Image size 2212x1659; CFP.
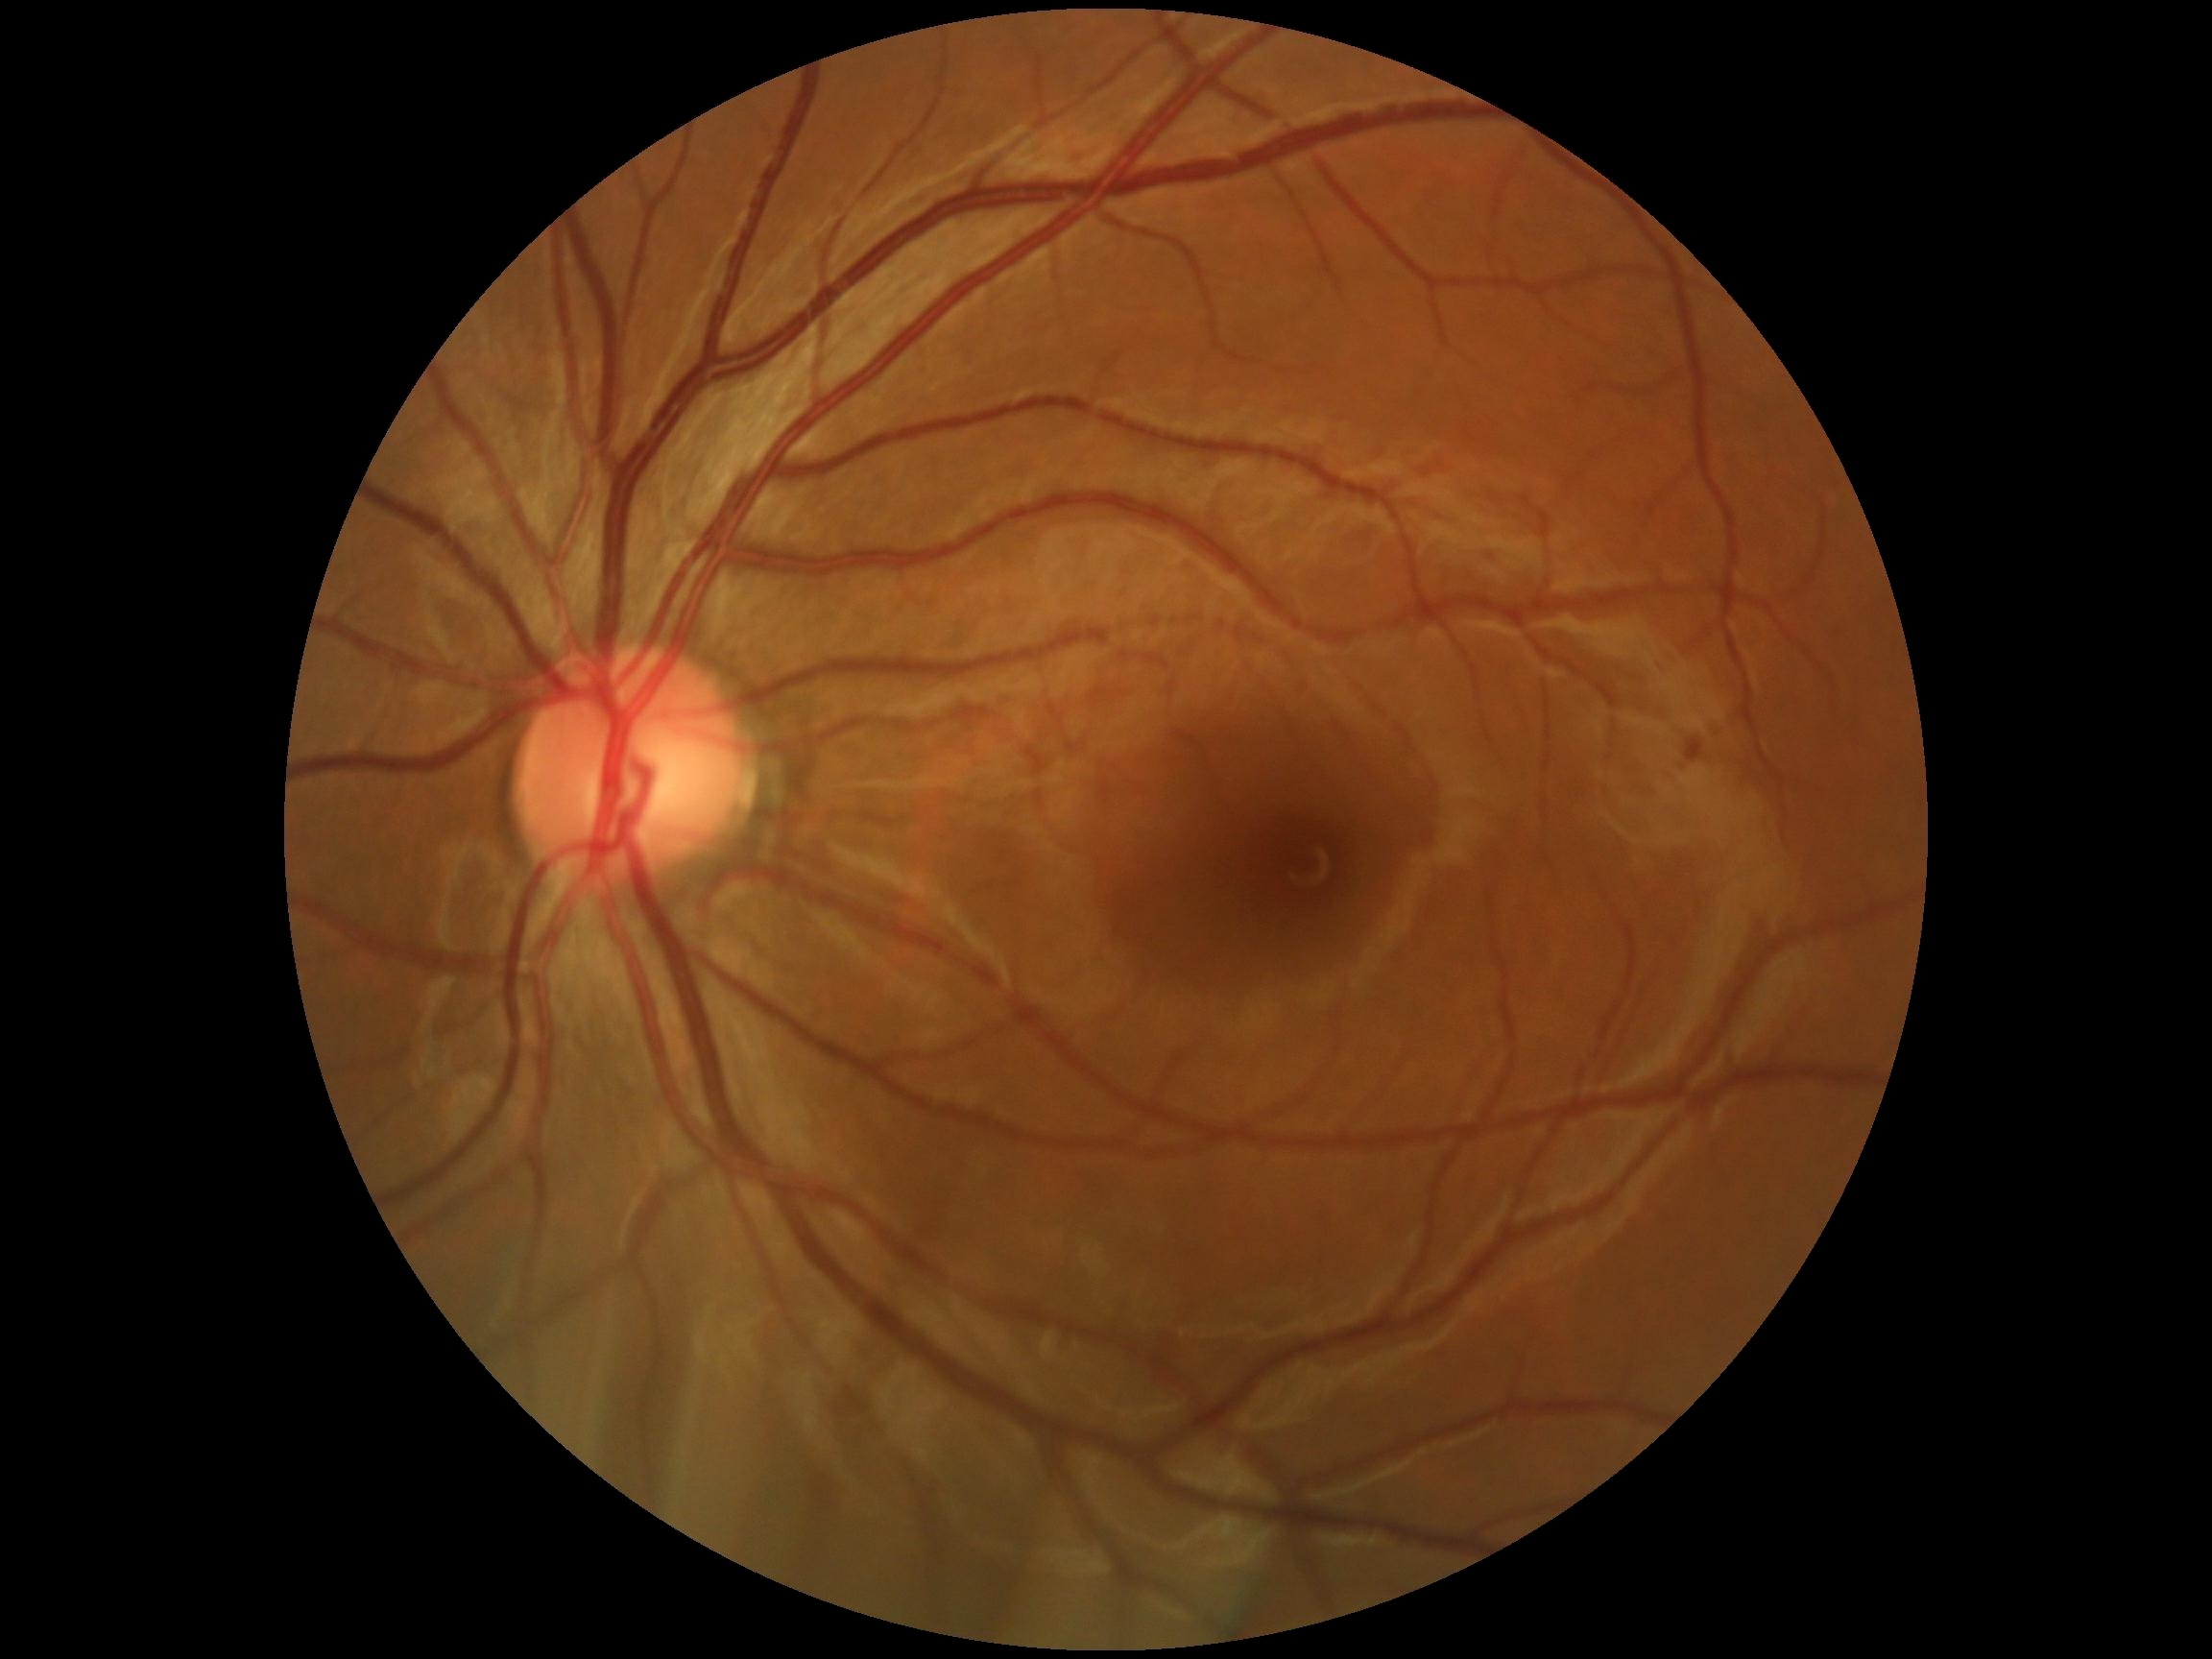
dr_impression: no signs of DR
dr_grade: 0/4